Graded on the modified Davis scale — 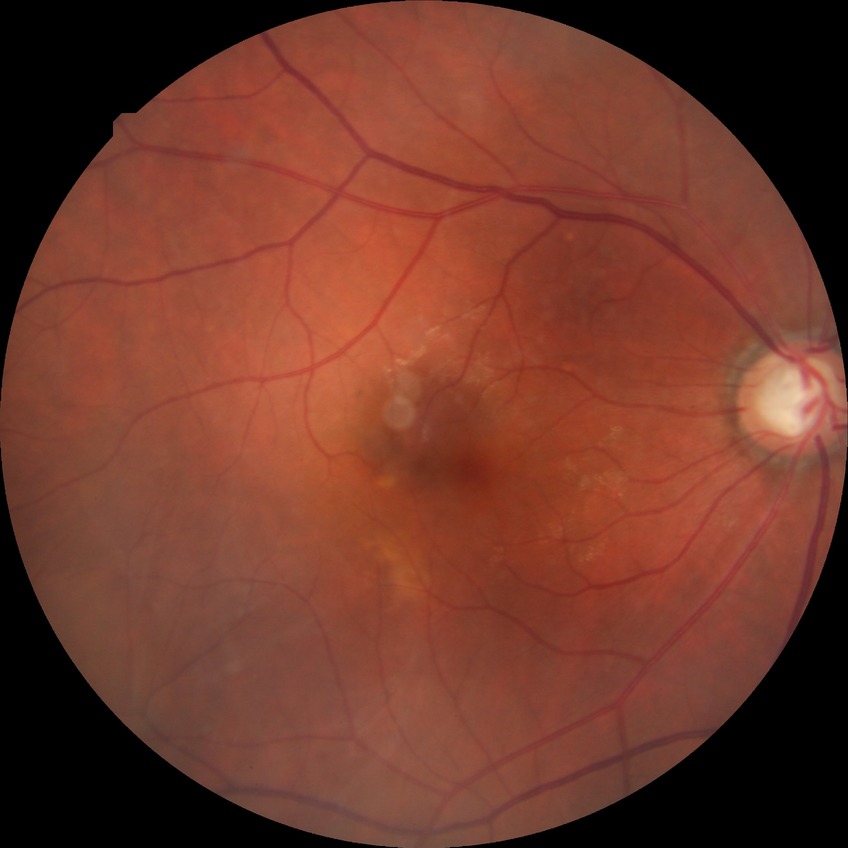

Diabetic retinopathy (DR): simple diabetic retinopathy (SDR). DR class: non-proliferative diabetic retinopathy.